Modified Davis classification. Nonmydriatic. 848x848 — 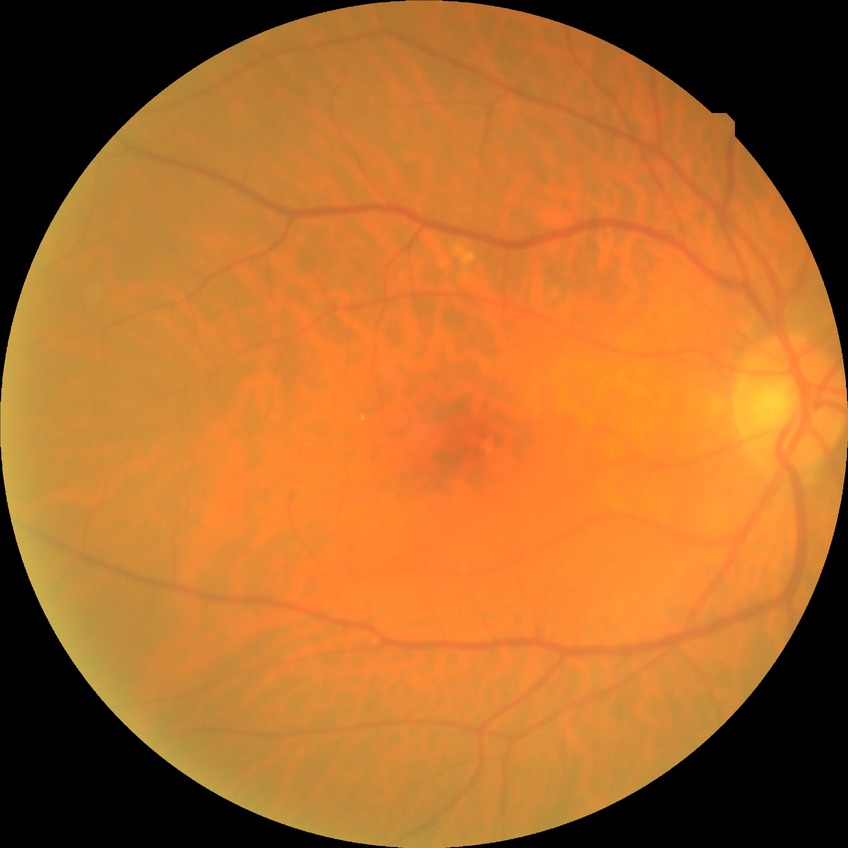

Diabetic retinopathy (DR): no diabetic retinopathy (NDR).